Optic nerve head photograph.
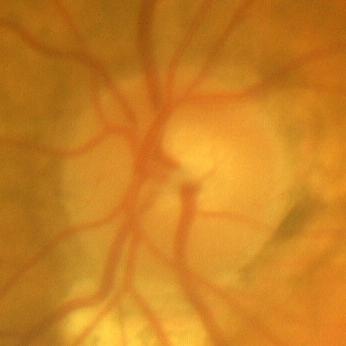

Showing no evidence of glaucoma.